Infant wide-field retinal image
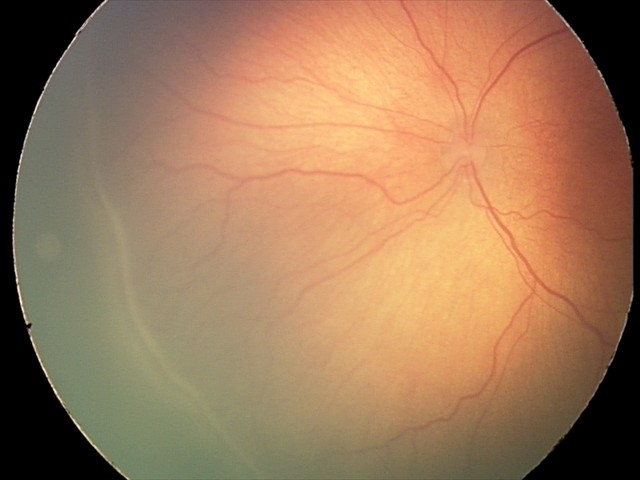

Plus disease absent. Screening examination consistent with ROP stage 2.